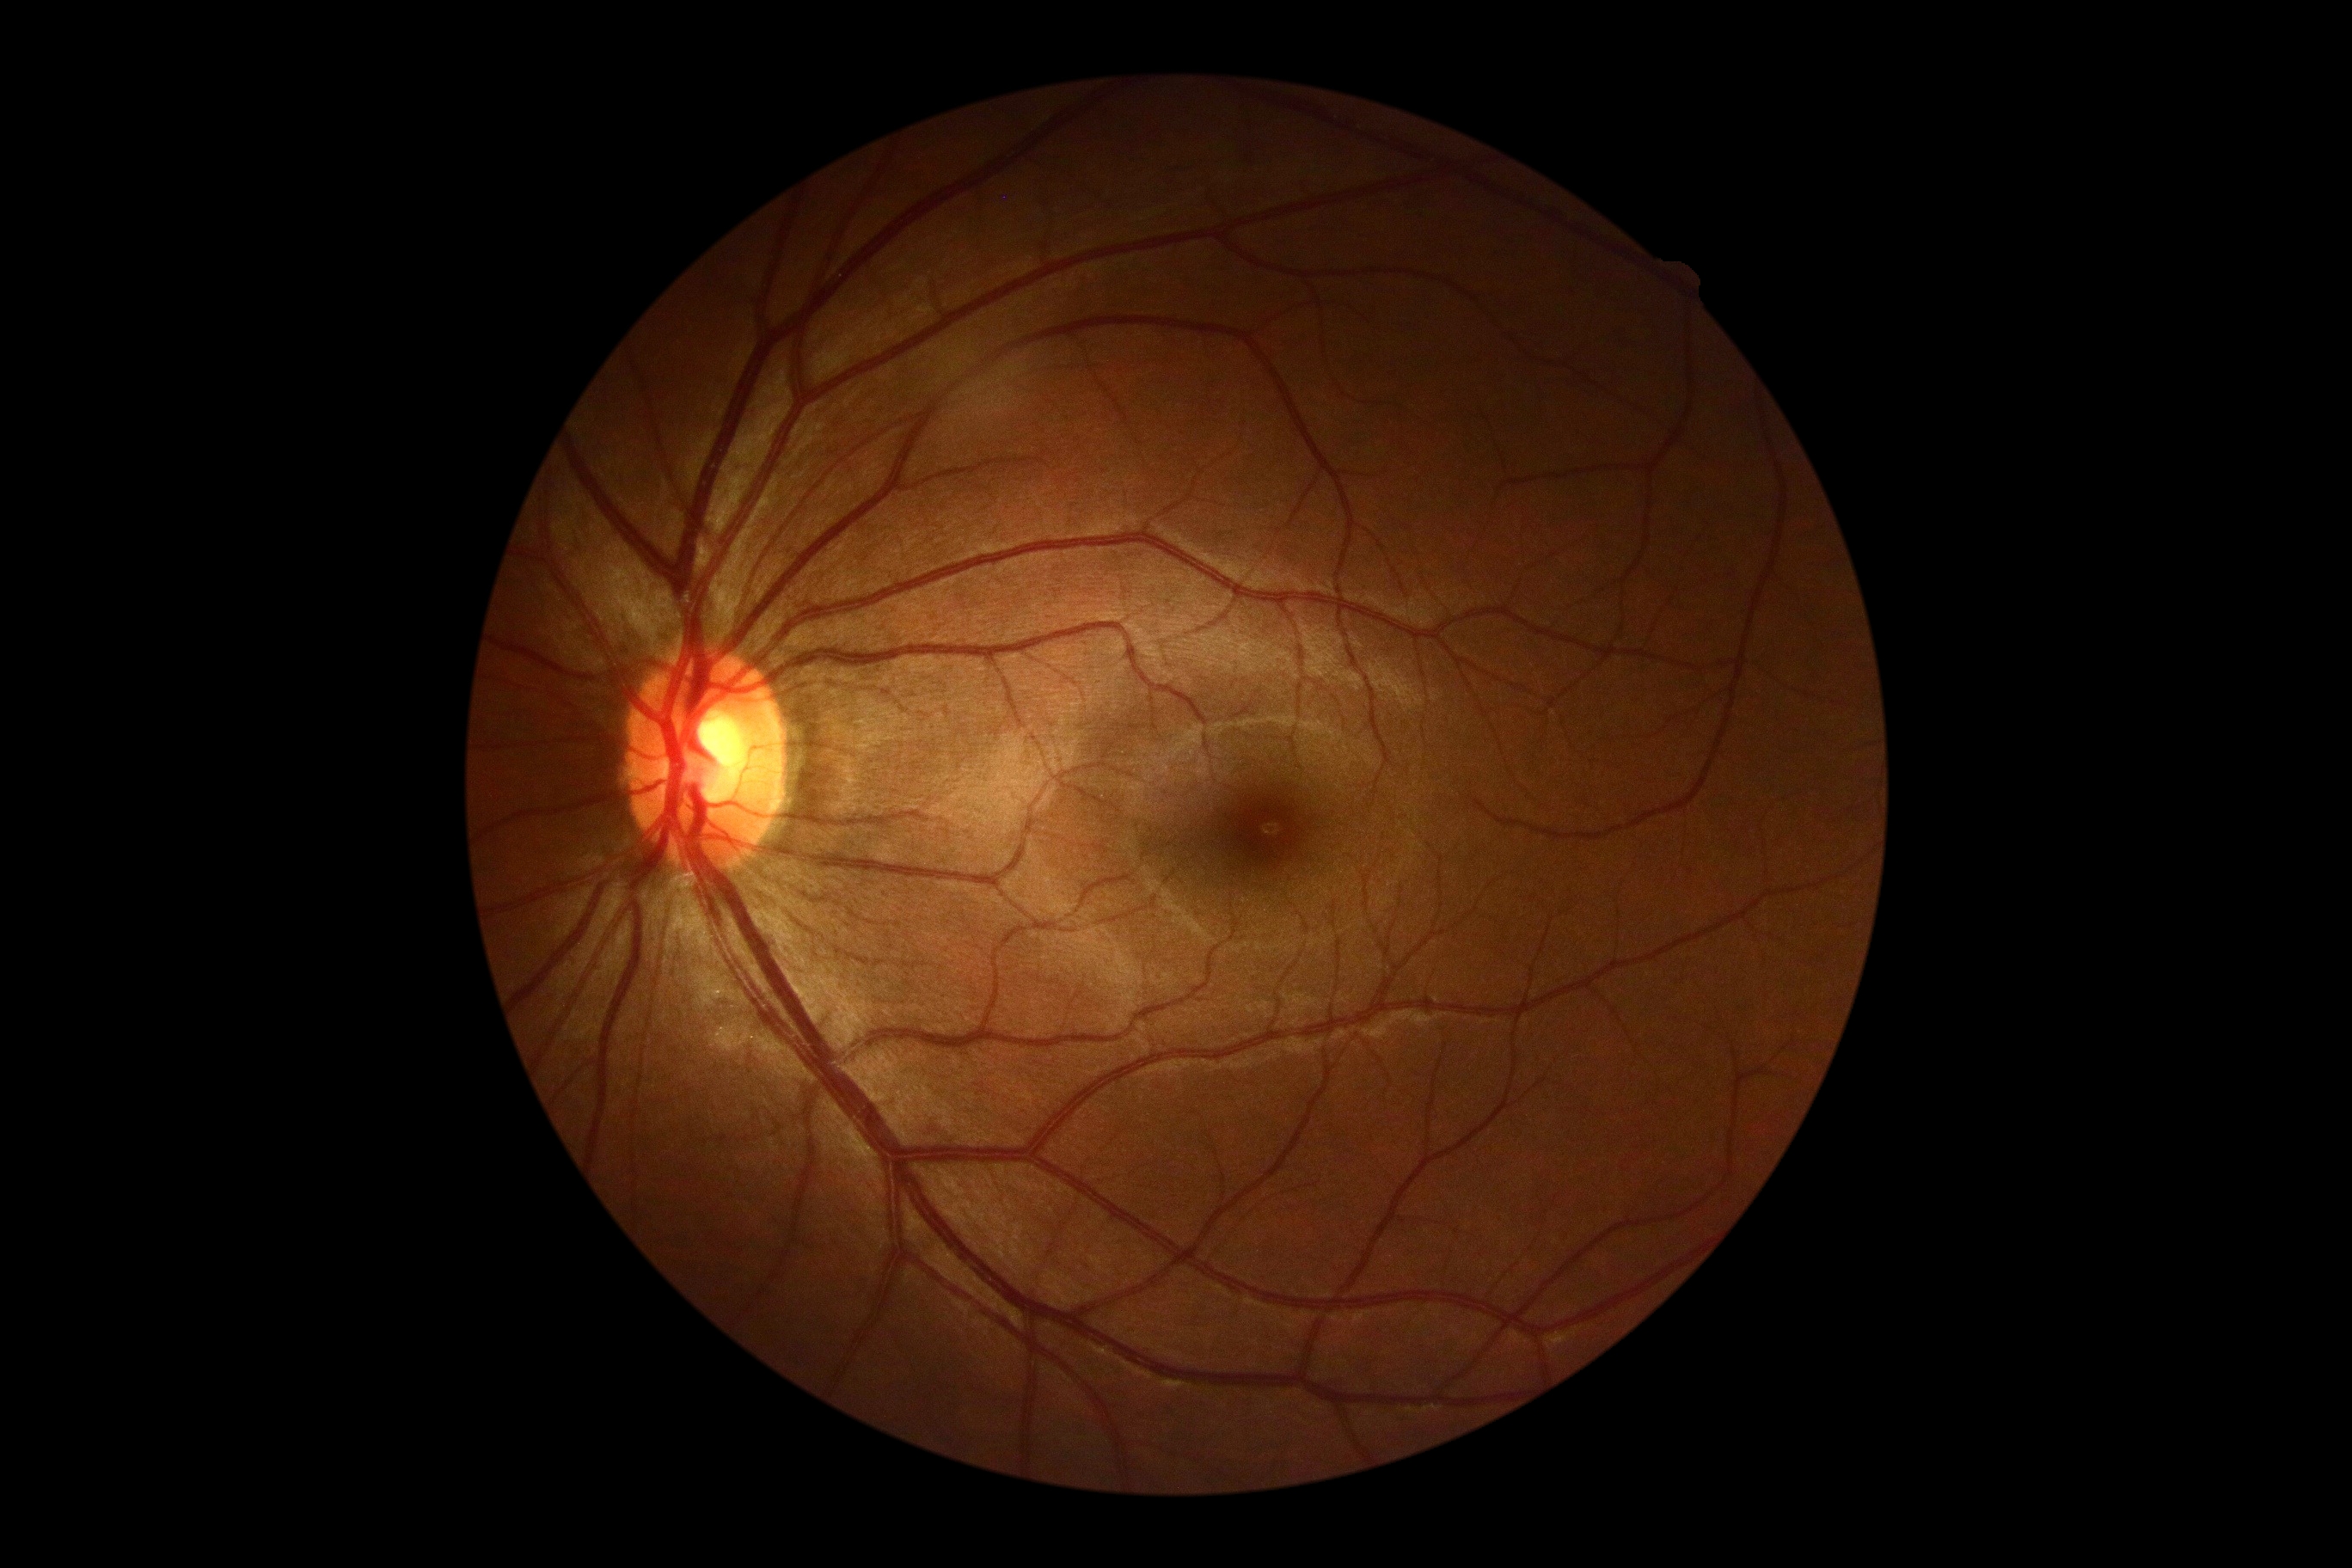

{"dr_grade": "grade 0 (no apparent retinopathy)"}